Wide-field fundus image from infant ROP screening. Camera: Clarity RetCam 3 (130° FOV). 640 x 480 pixels: 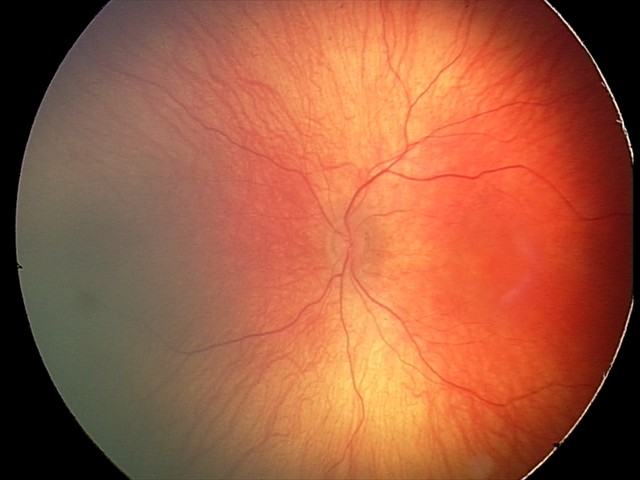
Screening examination with no abnormal retinal findings.